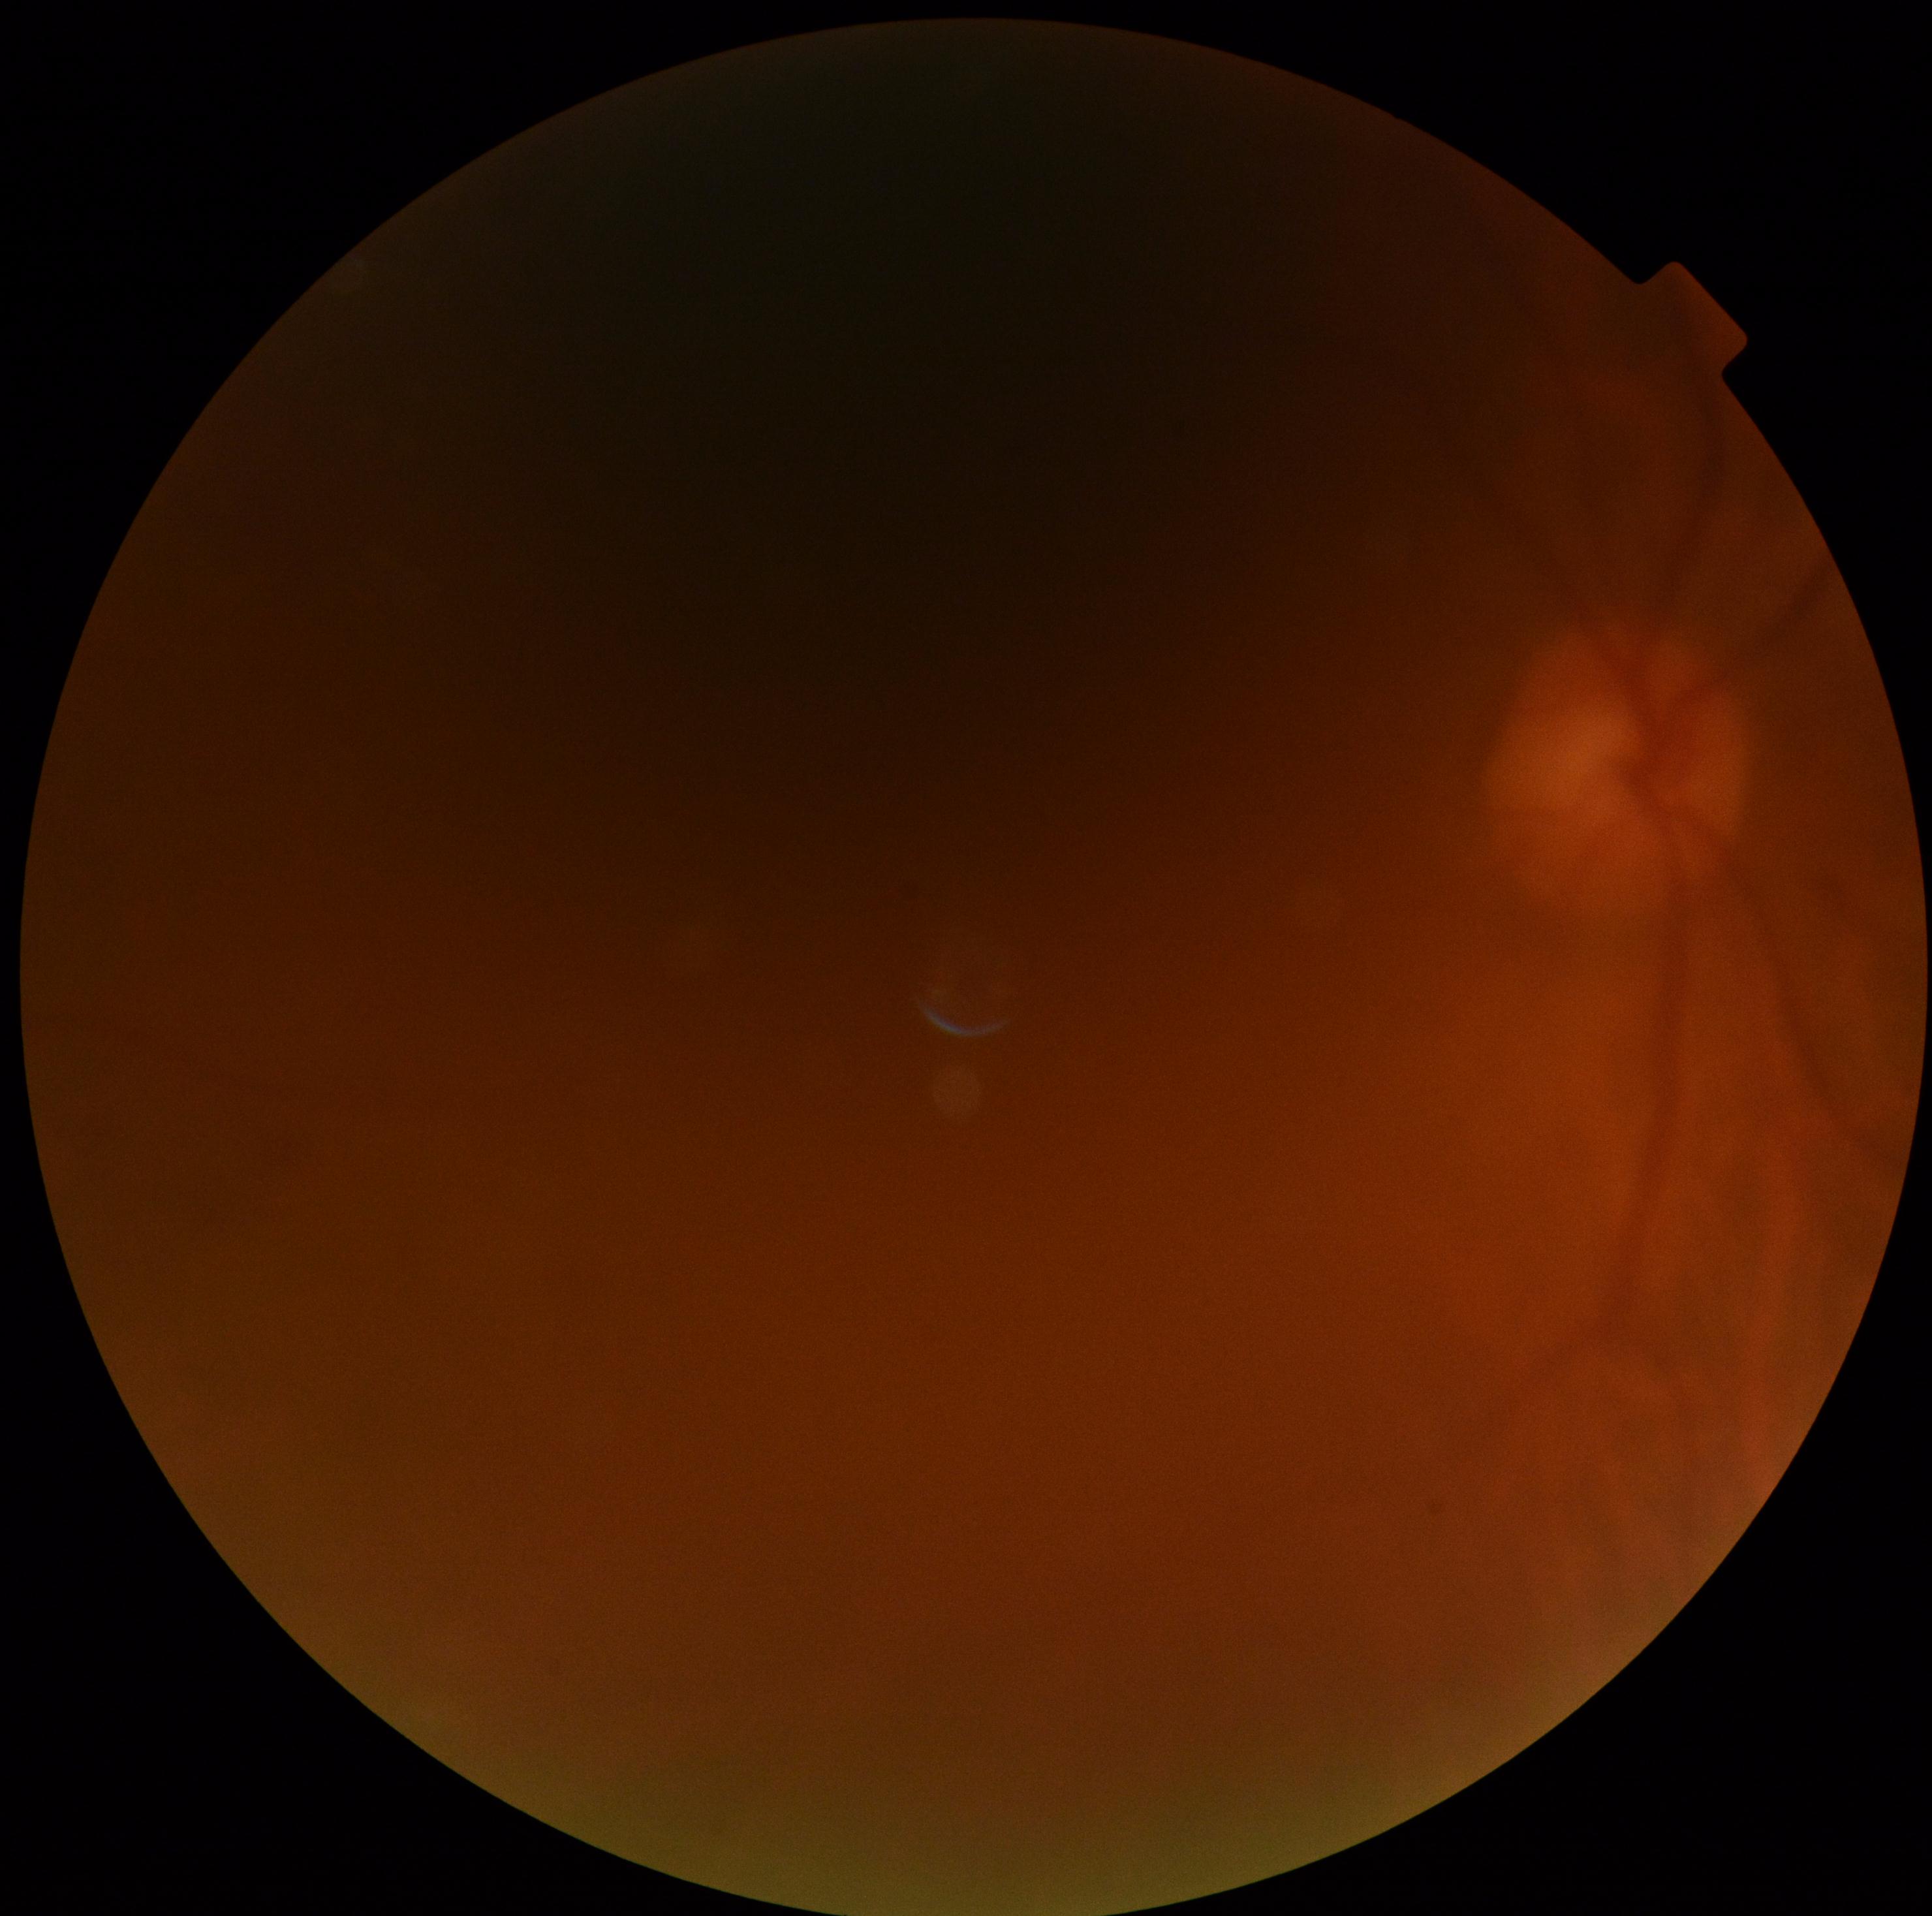

* diabetic retinopathy (DR) — ungradable
* image quality — below grading threshold